NIDEK AFC-230 fundus camera, nonmydriatic, 848 x 848 pixels:
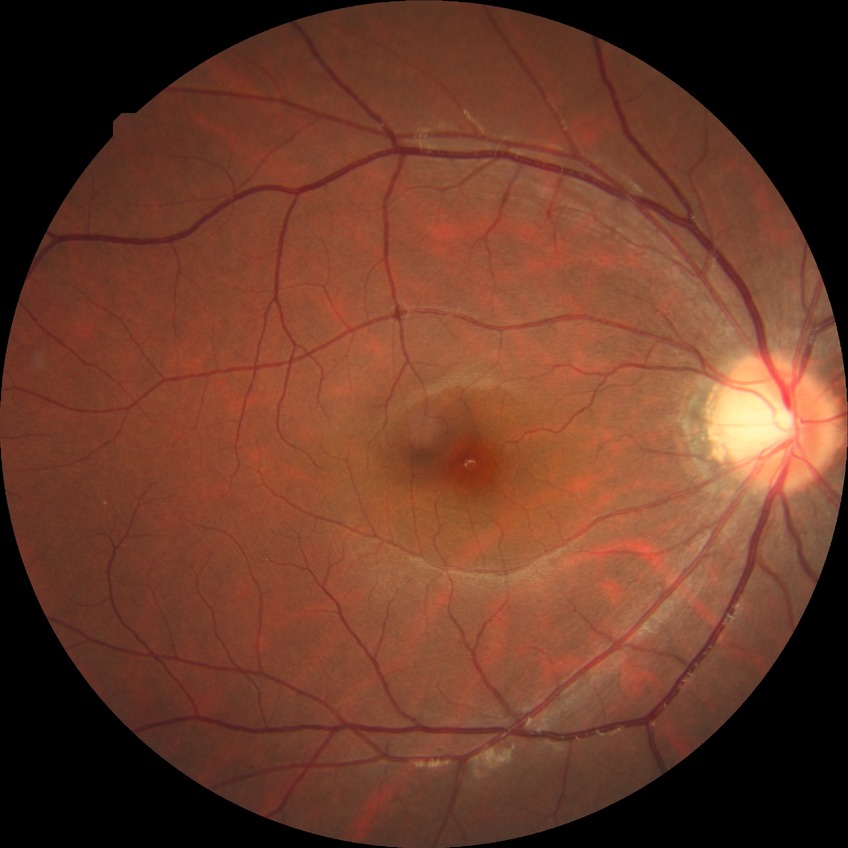 Diabetic retinopathy (DR): NDR (no diabetic retinopathy).